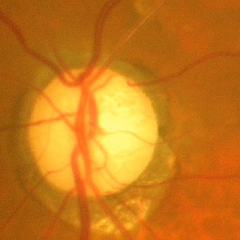 Advanced glaucoma.